Non-mydriatic acquisition, optic disc-centered crop: 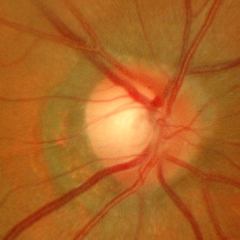 Glaucoma stage: early glaucomatous optic neuropathy.